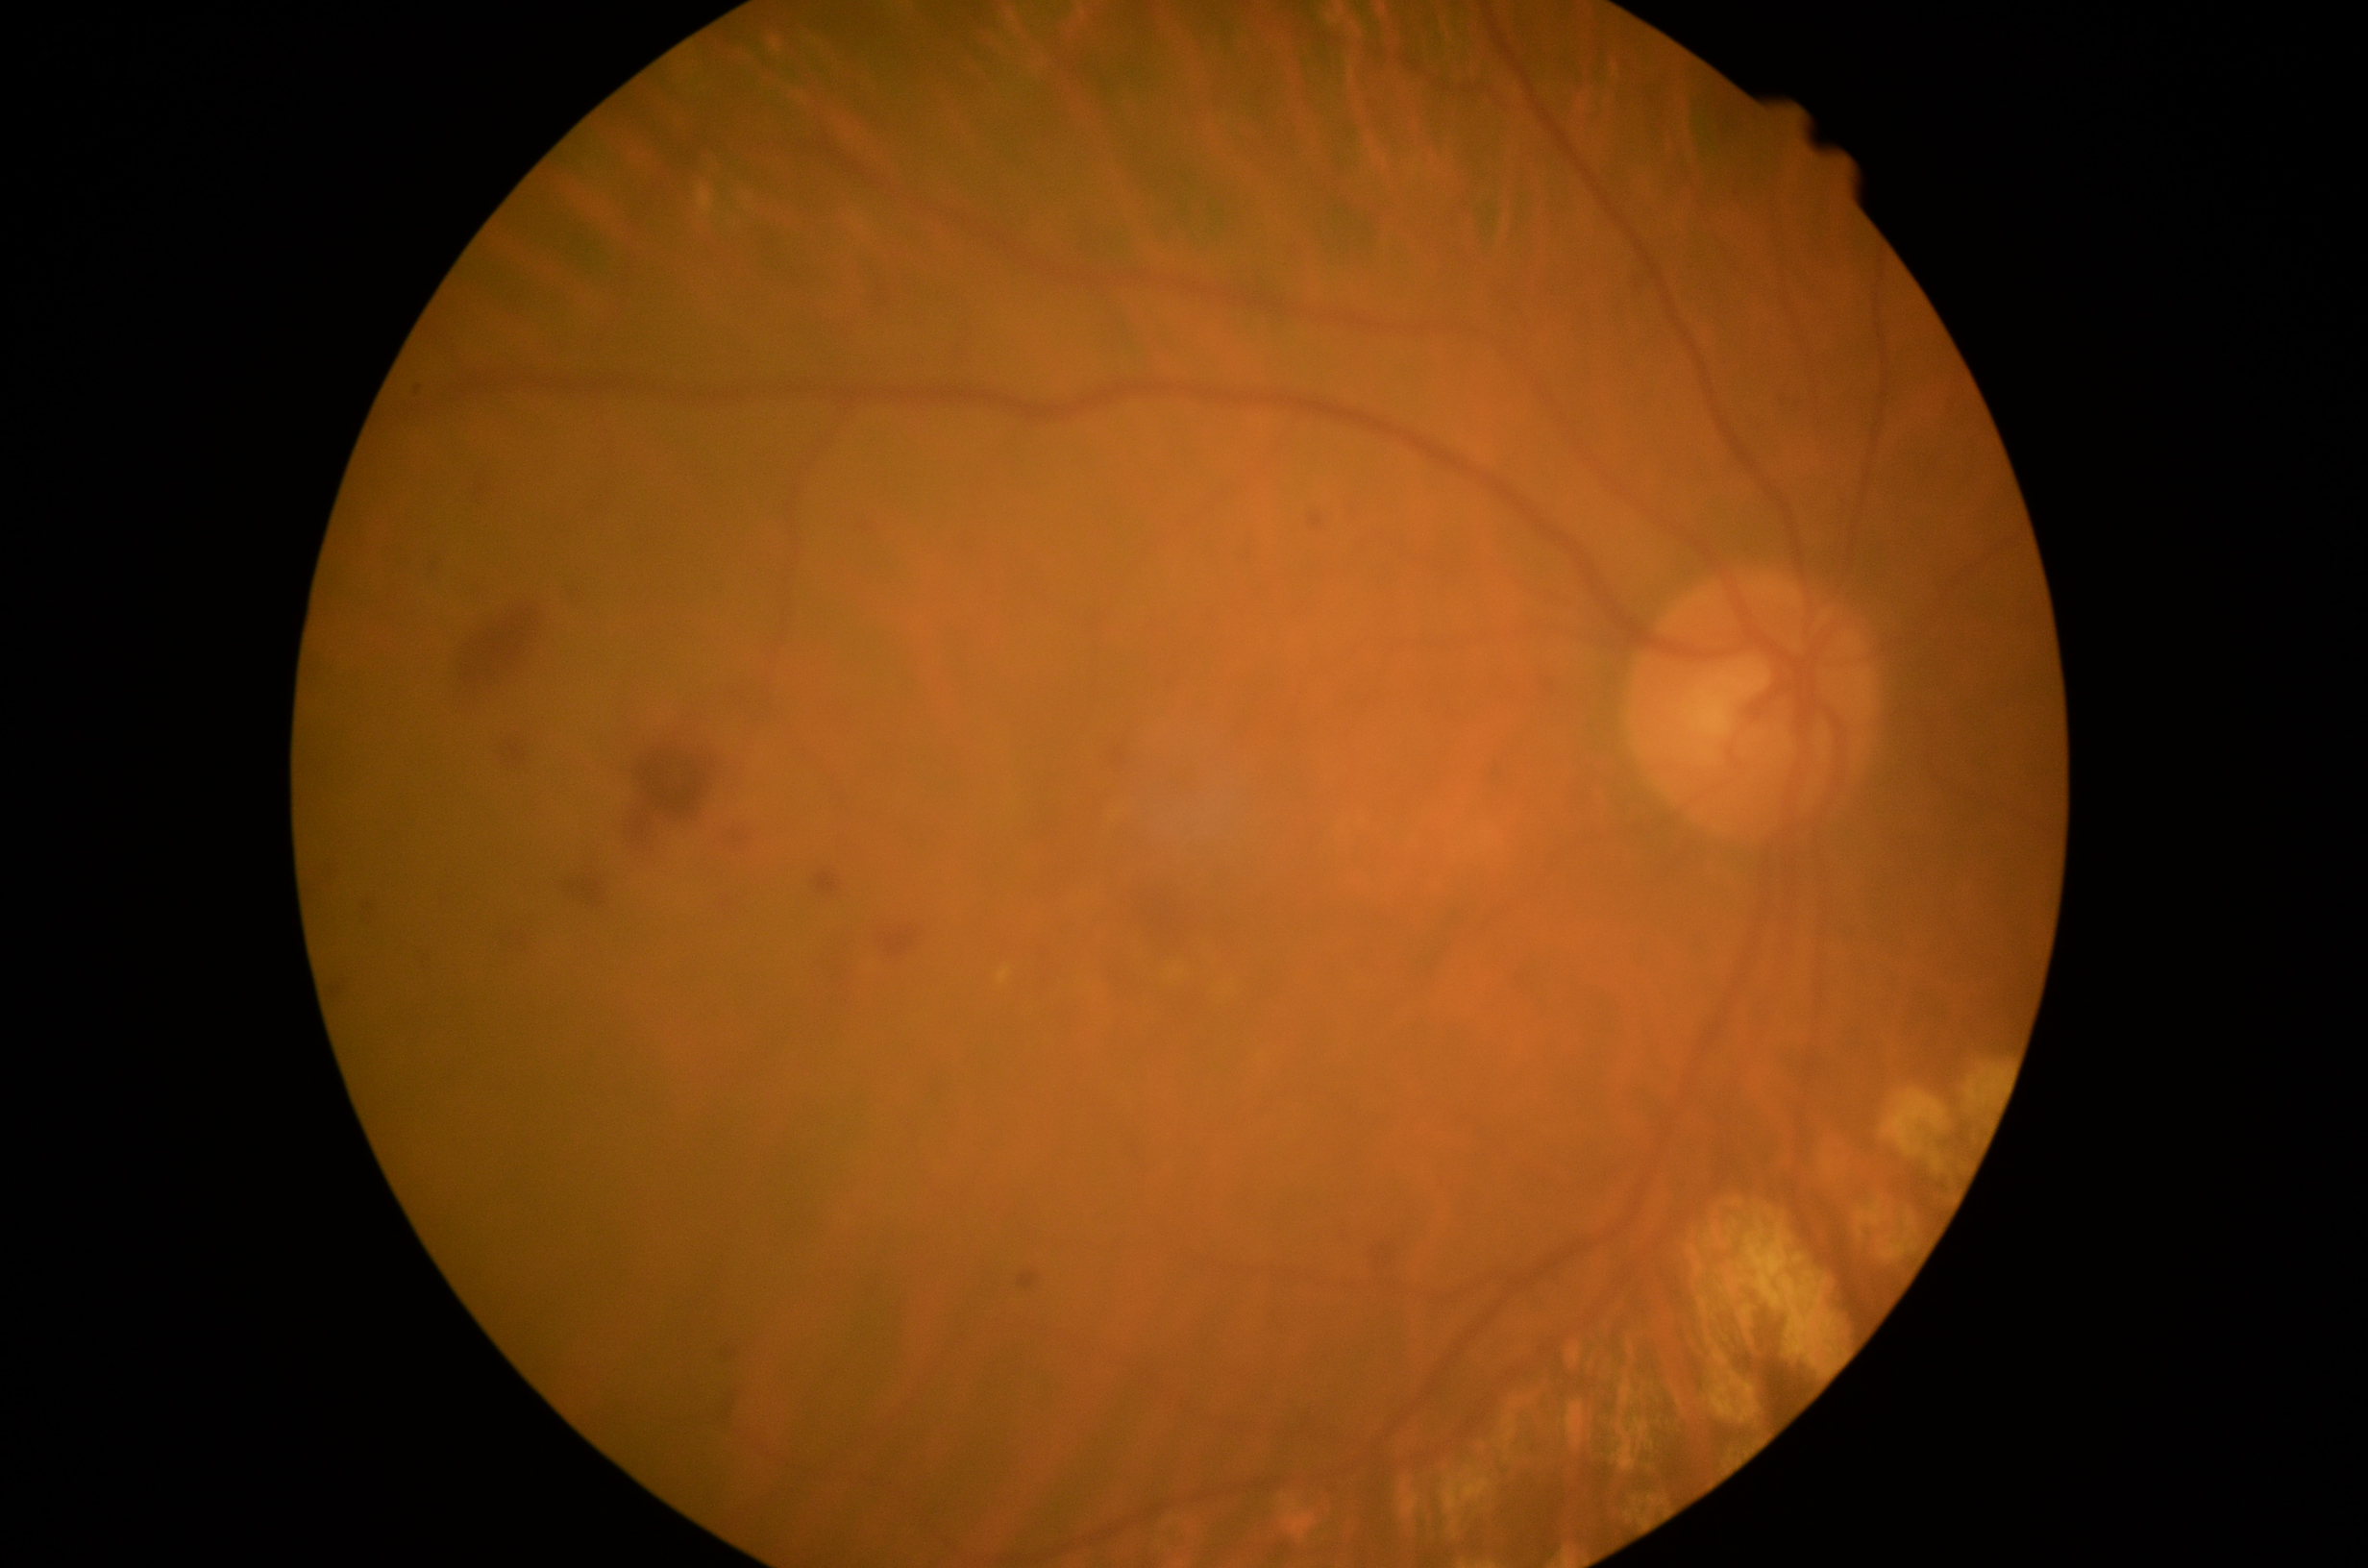 diabetic retinopathy severity: grade 2 (moderate NPDR).